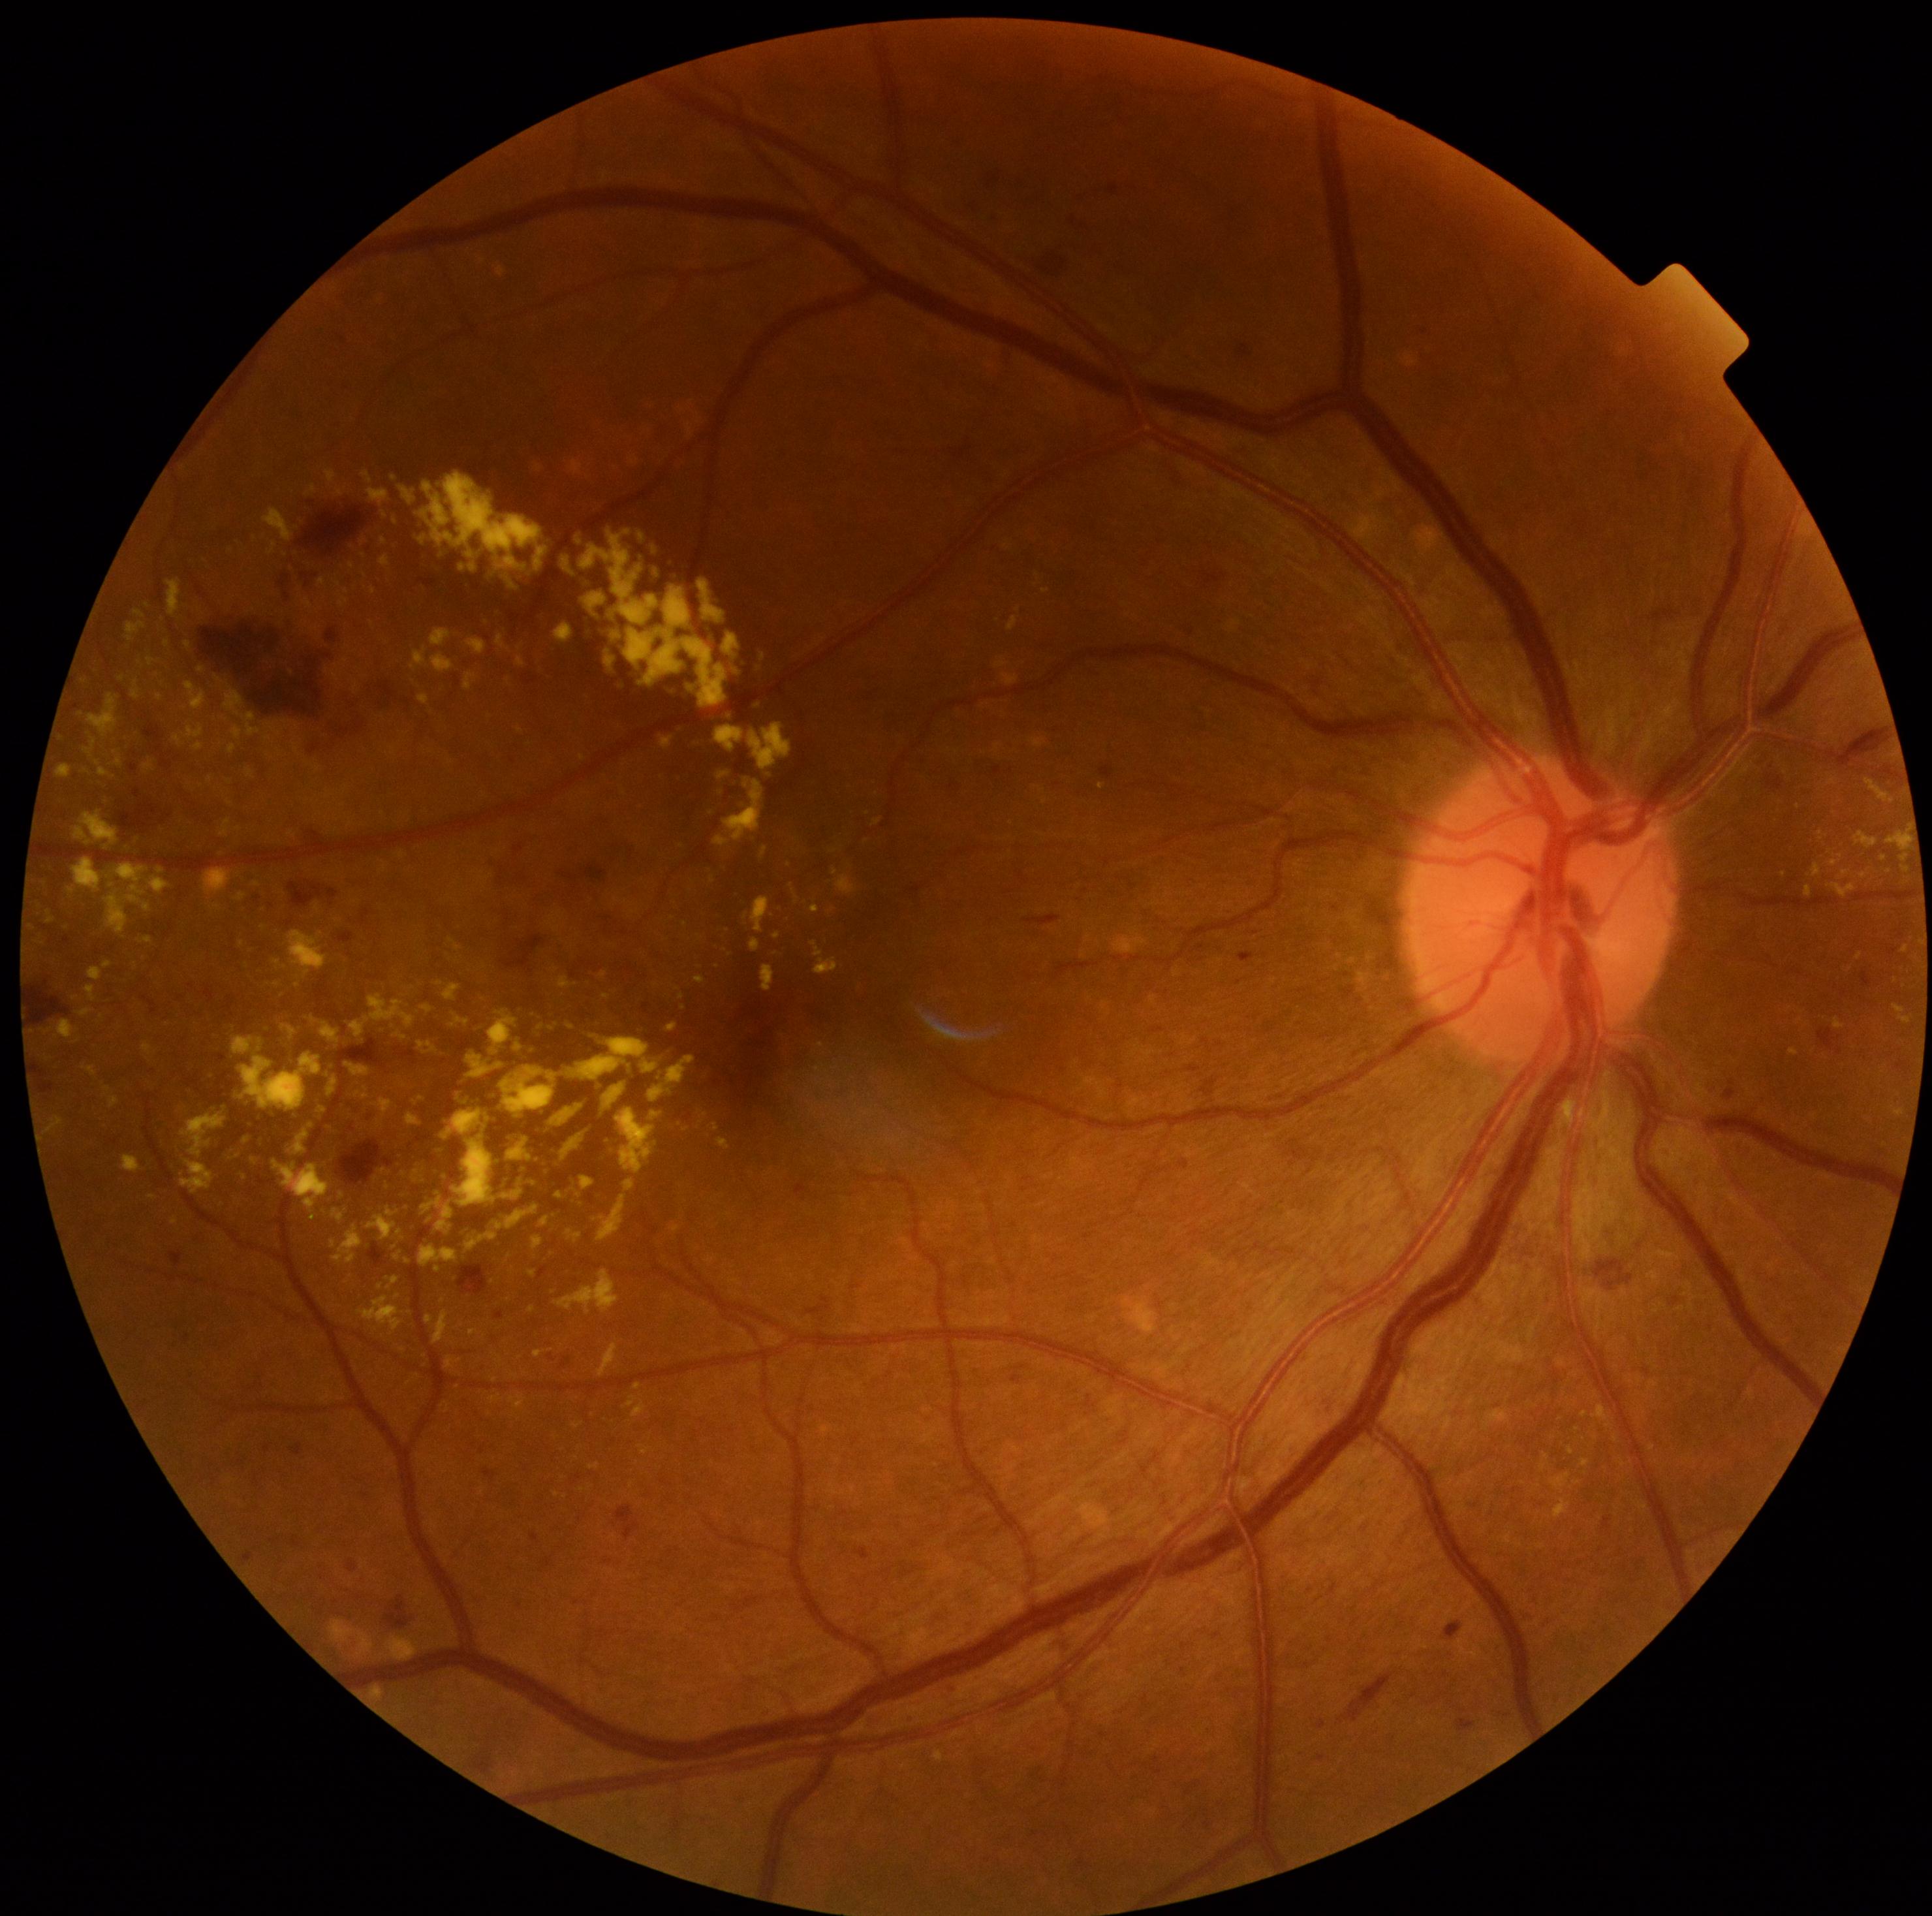

{"partial": true, "dr_grade": 2, "lesions": {"ex": [[395, 1033, 407, 1039], [373, 1098, 394, 1118], [695, 977, 707, 984], [358, 1086, 369, 1099], [399, 851, 407, 859], [220, 820, 230, 837], [46, 913, 55, 924], [811, 941, 839, 974], [156, 868, 165, 873], [302, 598, 317, 612], [548, 911, 565, 932], [555, 1269, 621, 1313]], "ex_small": [[746, 916], [364, 556], [316, 628], [78, 1041], [440, 983], [657, 985], [509, 681], [372, 625]]}}